Nonmydriatic.
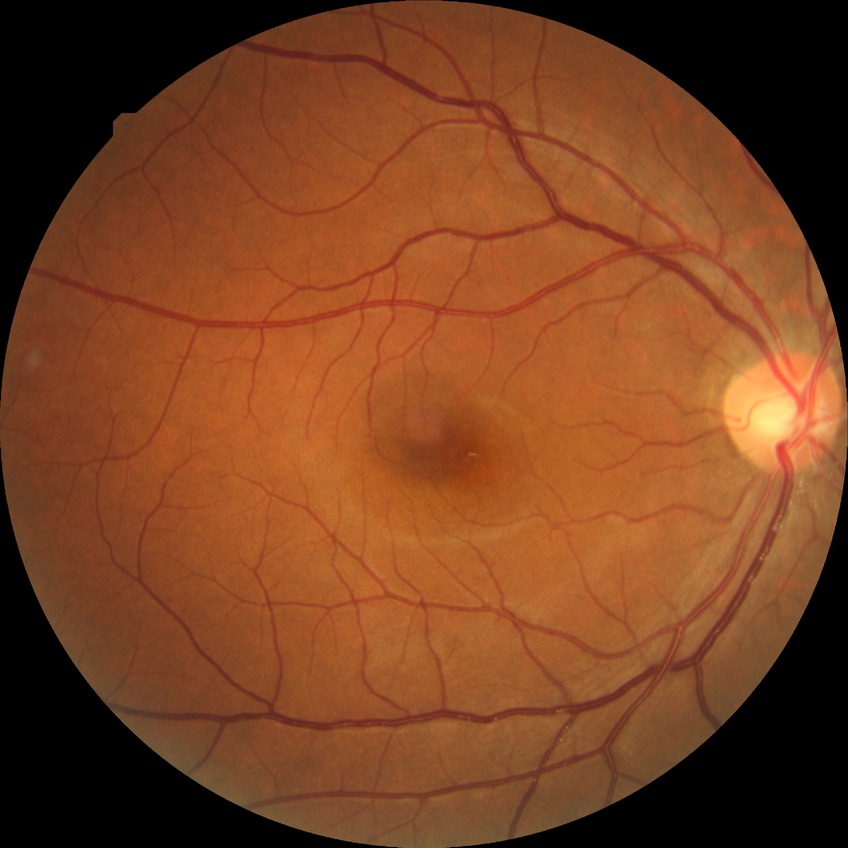
Retinopathy stage: no diabetic retinopathy.